Camera: NIDEK AFC-230 — 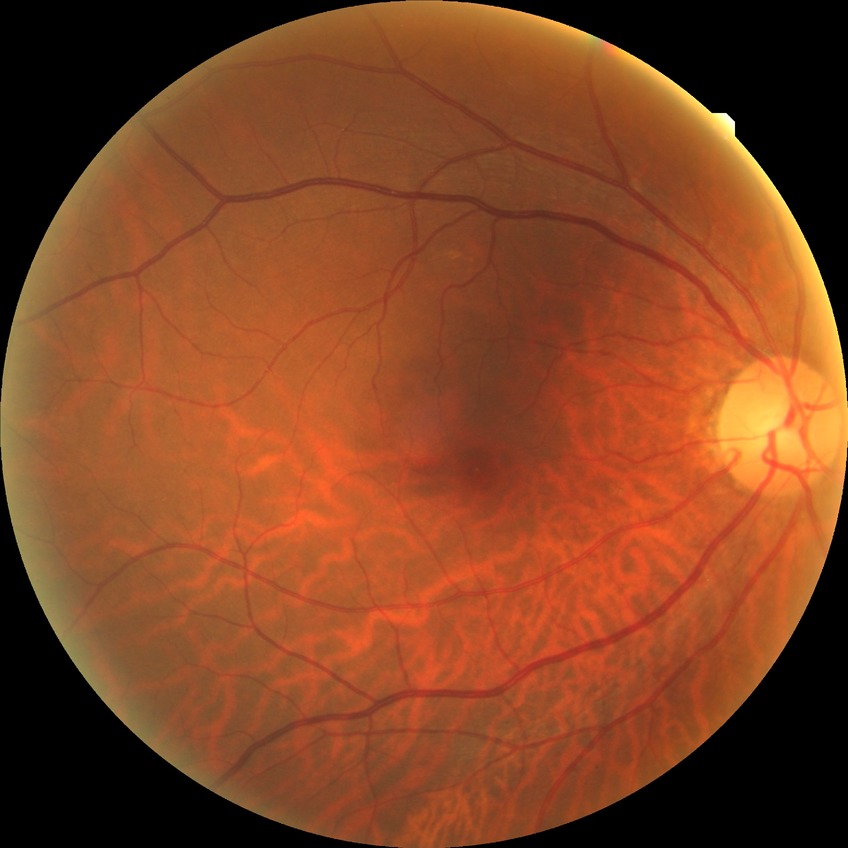 DR grade: NDR.